Acquired with a Nidek AFC-330, 240x240px, captured without pupil dilation.
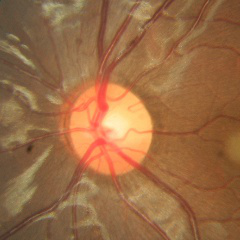 Fundus appearance consistent with no glaucomatous changes.